640 by 480 pixels · pediatric wide-field fundus photograph · captured with the Clarity RetCam 3 (130° field of view): 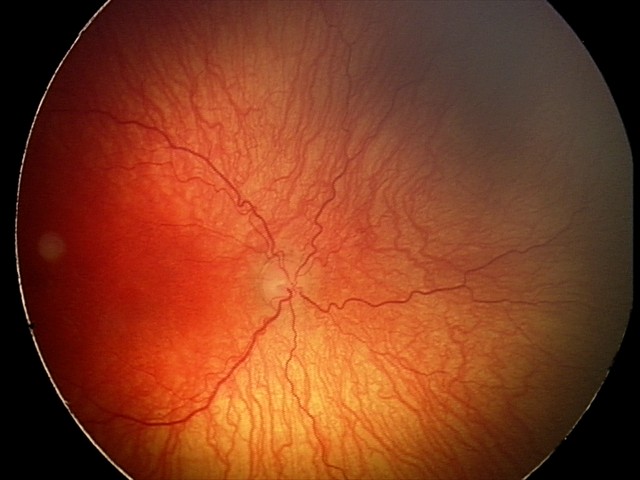 Examination diagnosed as aggressive ROP (A-ROP) — rapidly progressive severe ROP with prominent plus disease, often without classic stage progression.